45° FOV.
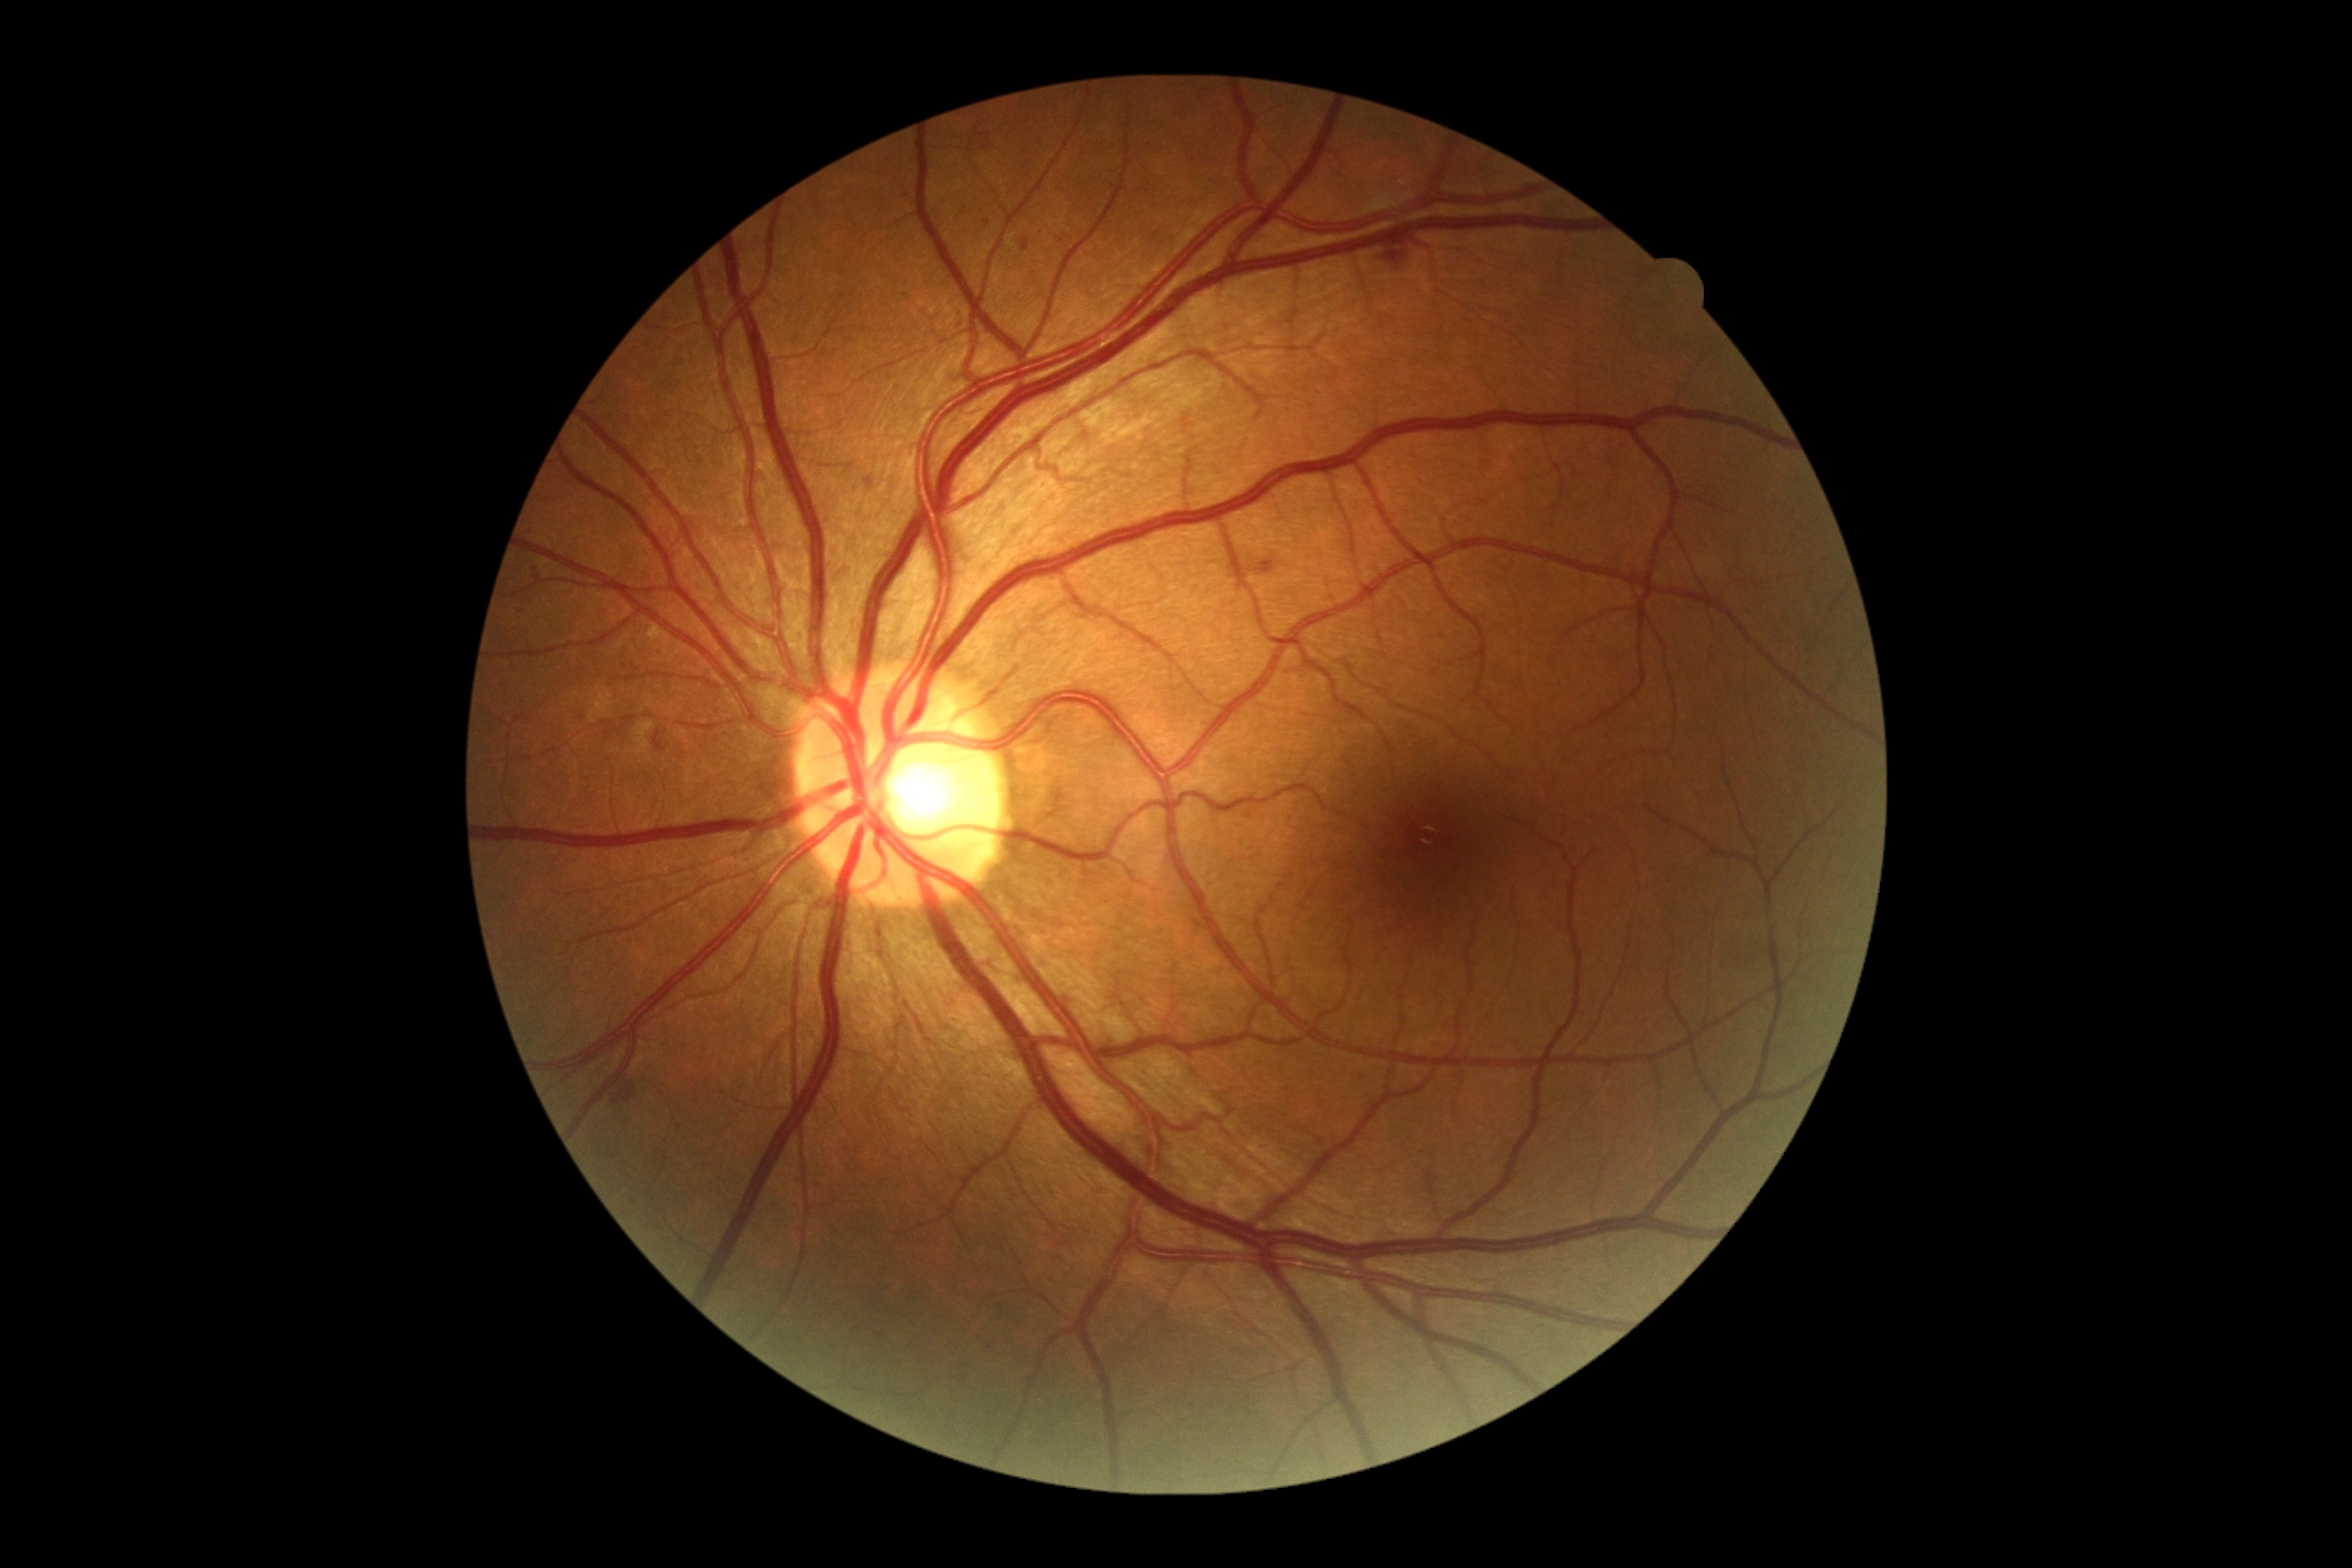

{"partial":true,"dr_grade":2,"dr_grade_name":"moderate NPDR","lesions":{"ma":[[865,476,874,489],[1021,239,1028,251],[536,576,545,583]],"ma_small_centers":[[536,570],[990,1349],[679,1128],[987,223]],"ex":null,"he":[[654,730,665,750],[1255,560,1275,574],[1386,251,1406,264],[612,1084,636,1104]],"se":null}}